Nonmydriatic, 45° field of view, camera: NIDEK AFC-230, modified Davis classification.
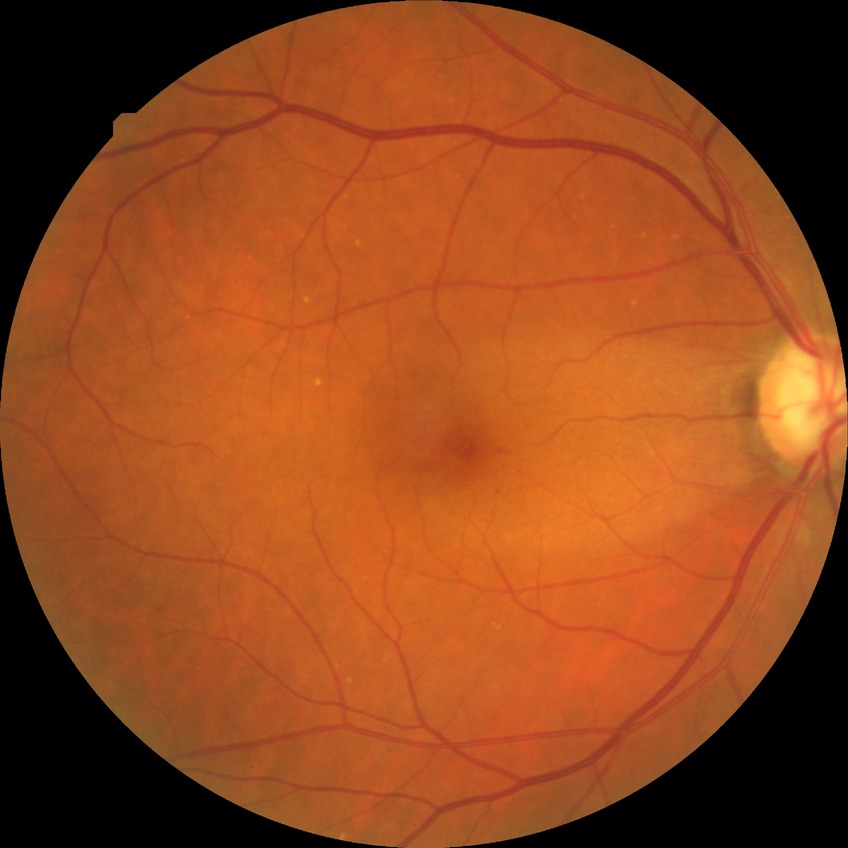

  davis_grade: SDR